Color fundus photograph
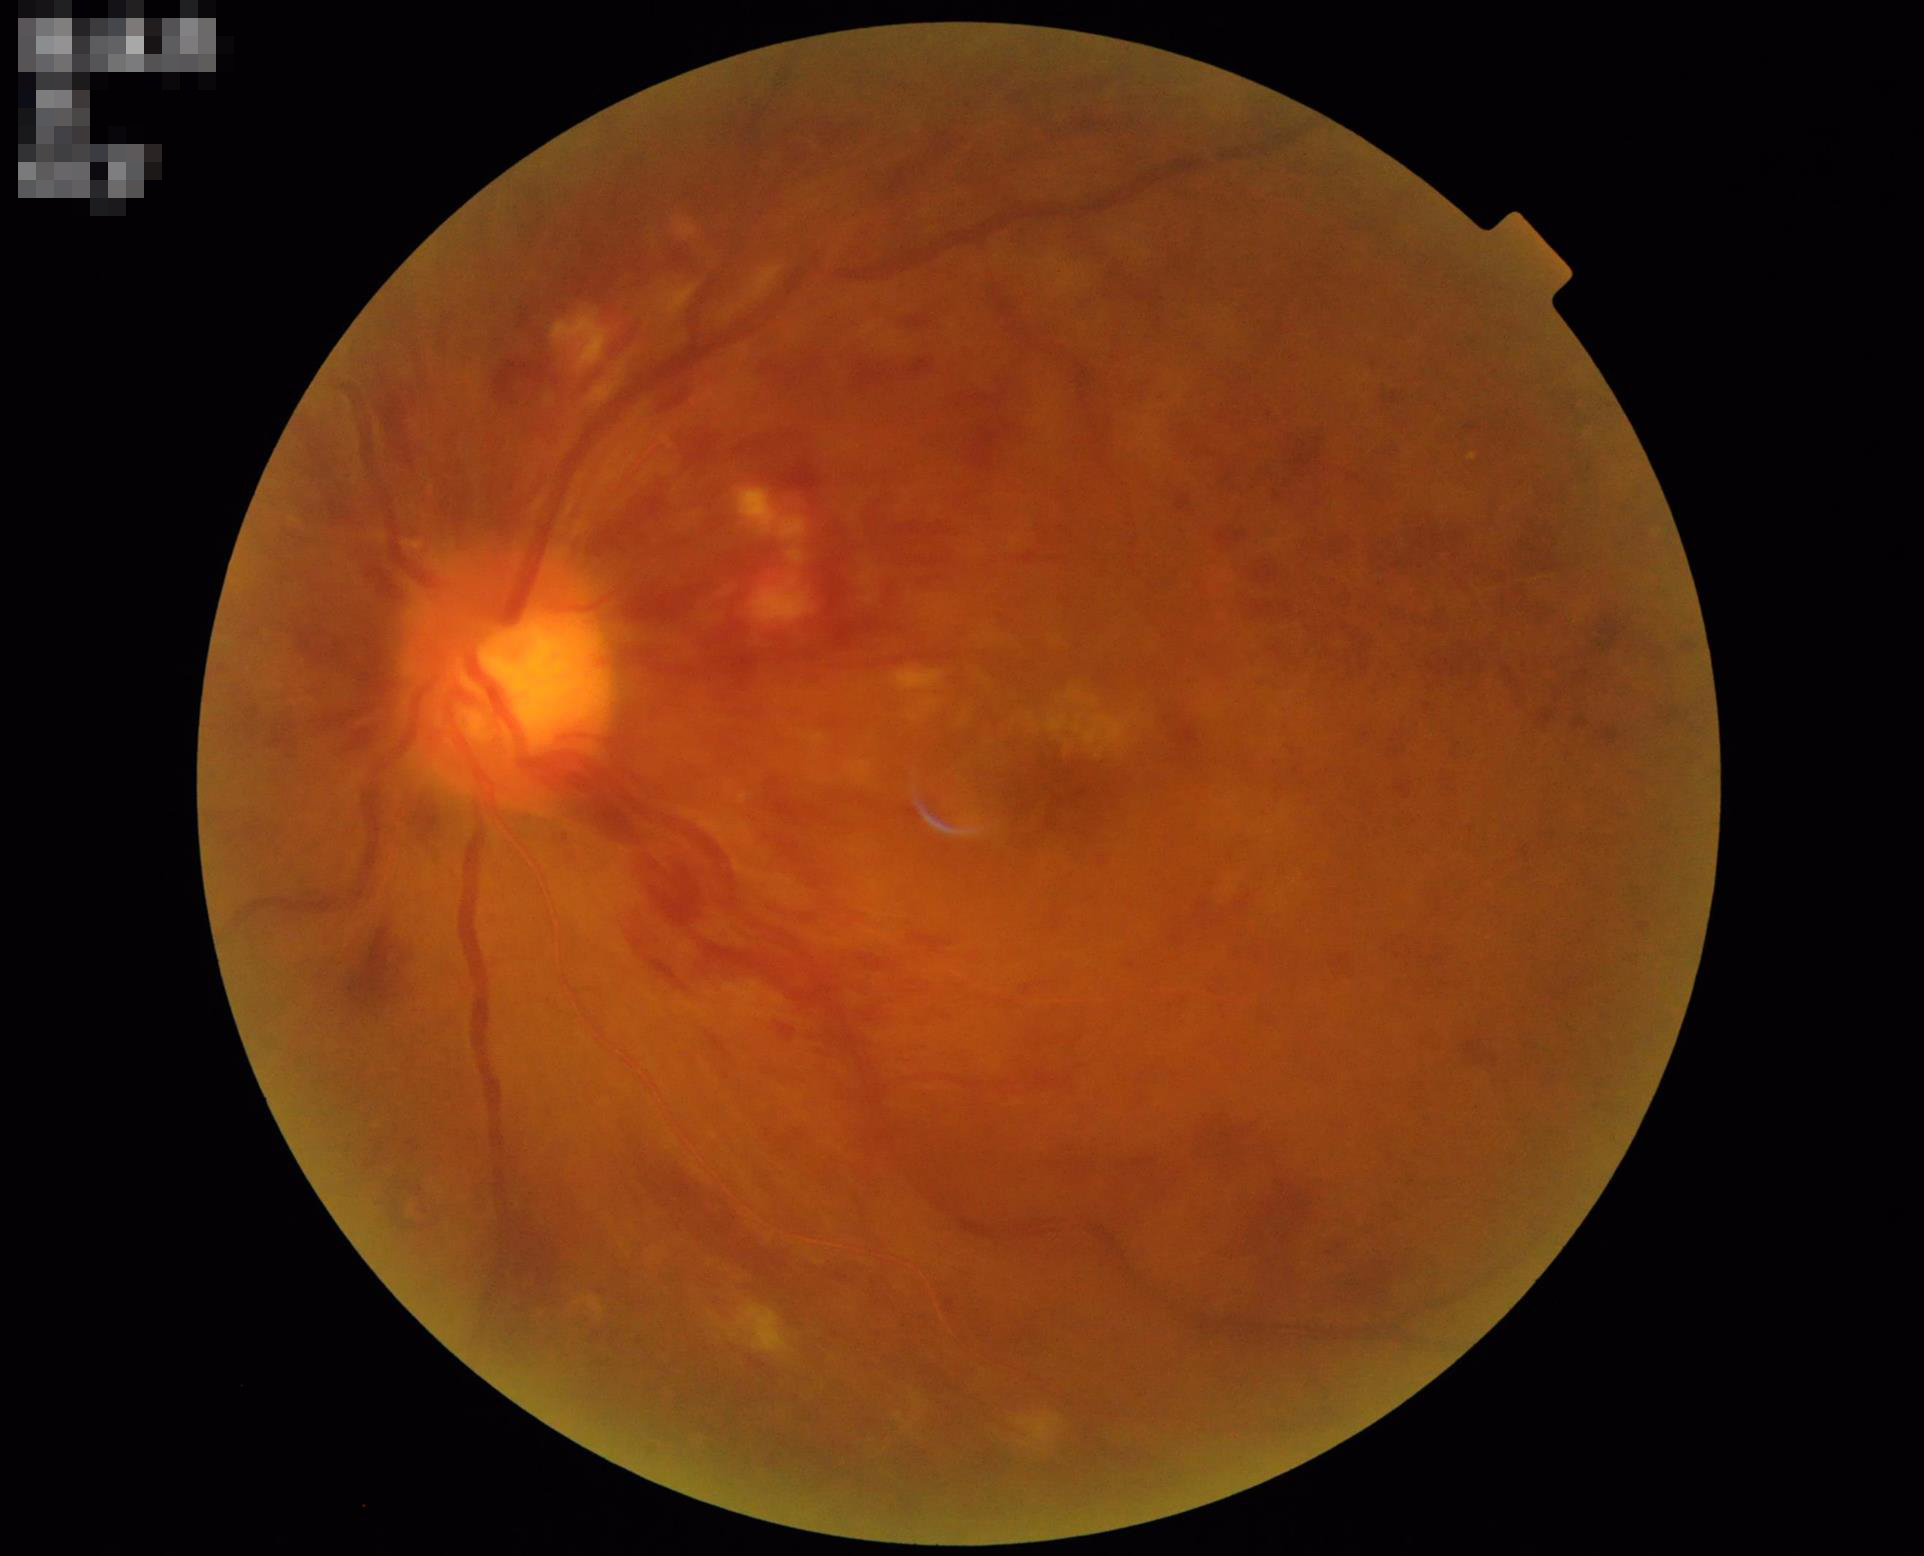 The image is blurry.
Overall quality is poor; the image is difficult to grade.
Illumination and color balance are good.
Poor dynamic range.